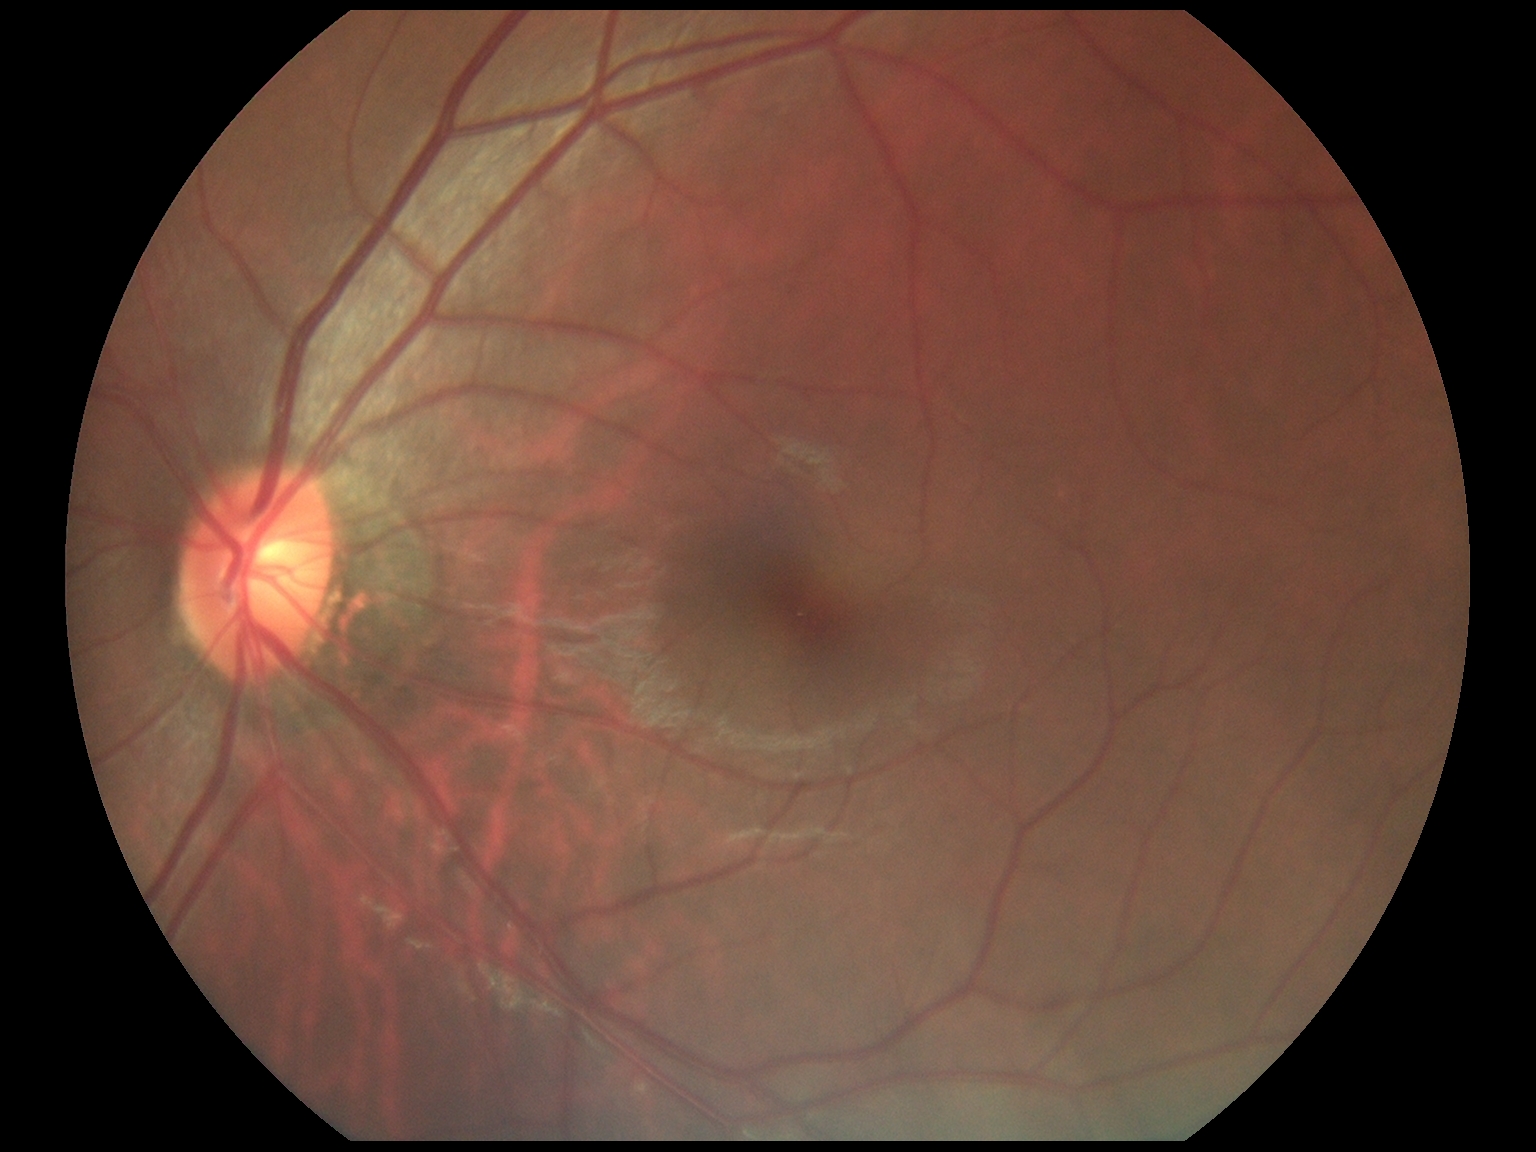
Retinopathy grade: no apparent diabetic retinopathy (0).